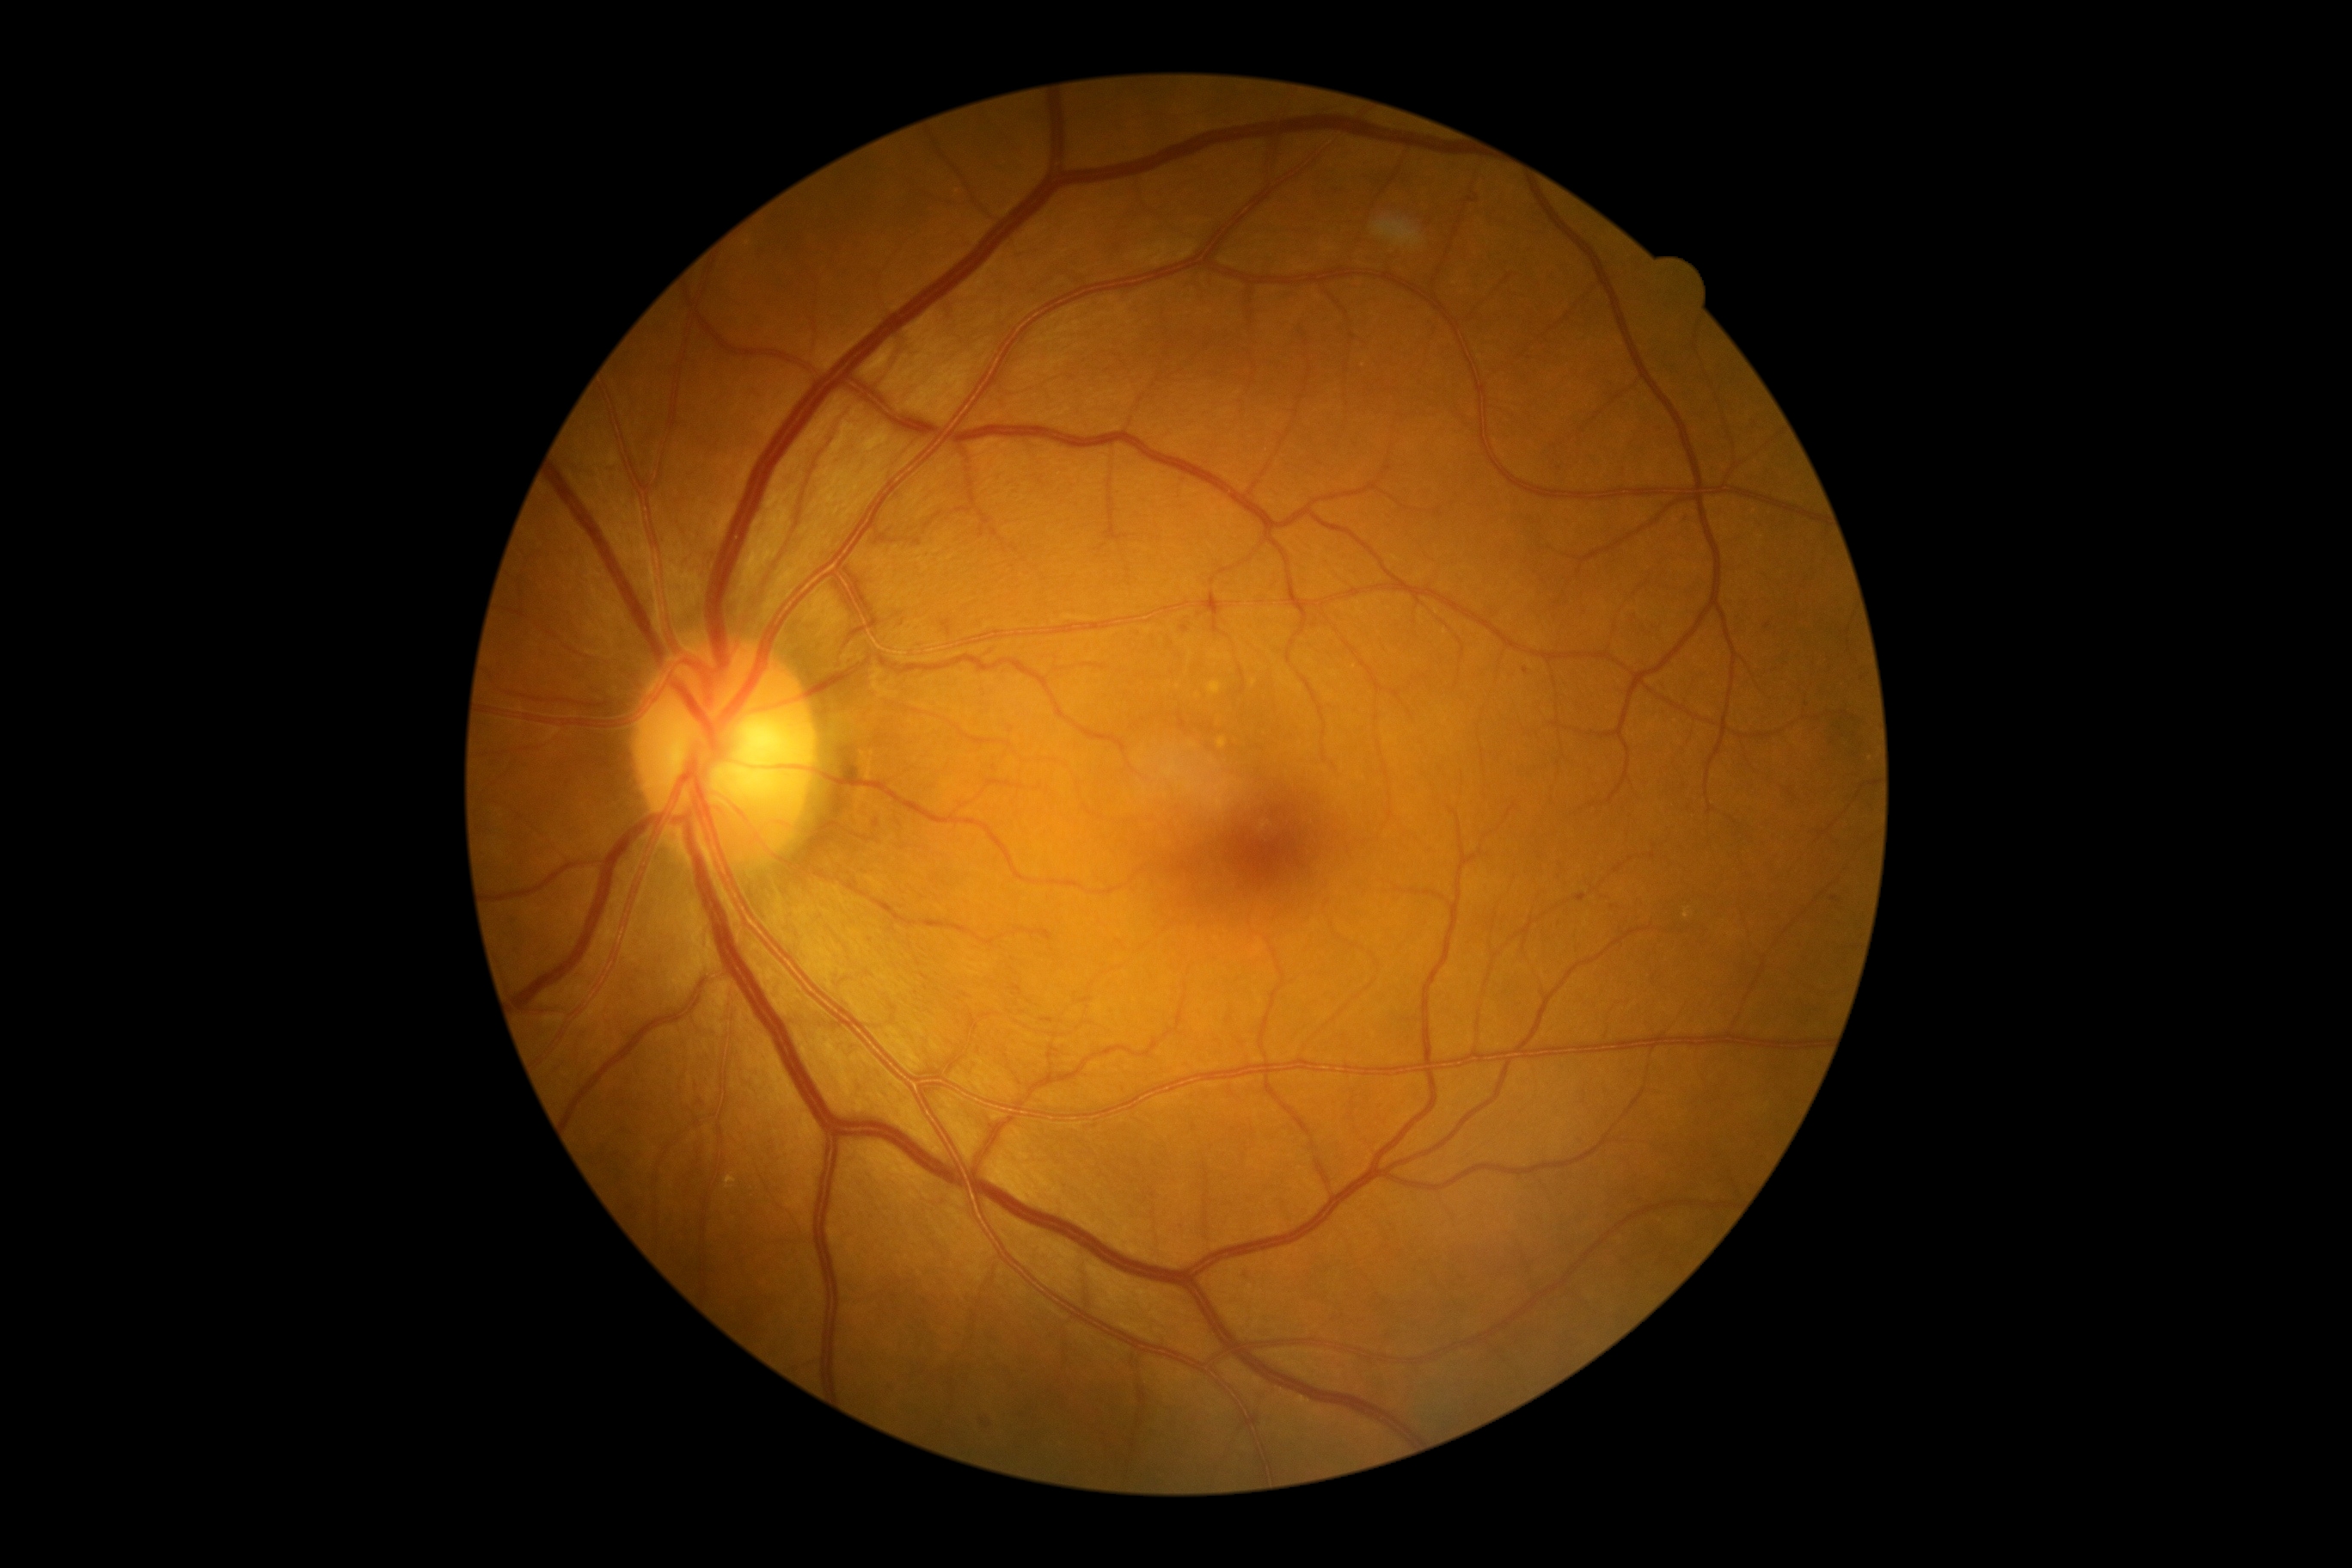 Diabetic retinopathy (DR) is 2/4 — more than just microaneurysms but less than severe NPDR.